CFP — 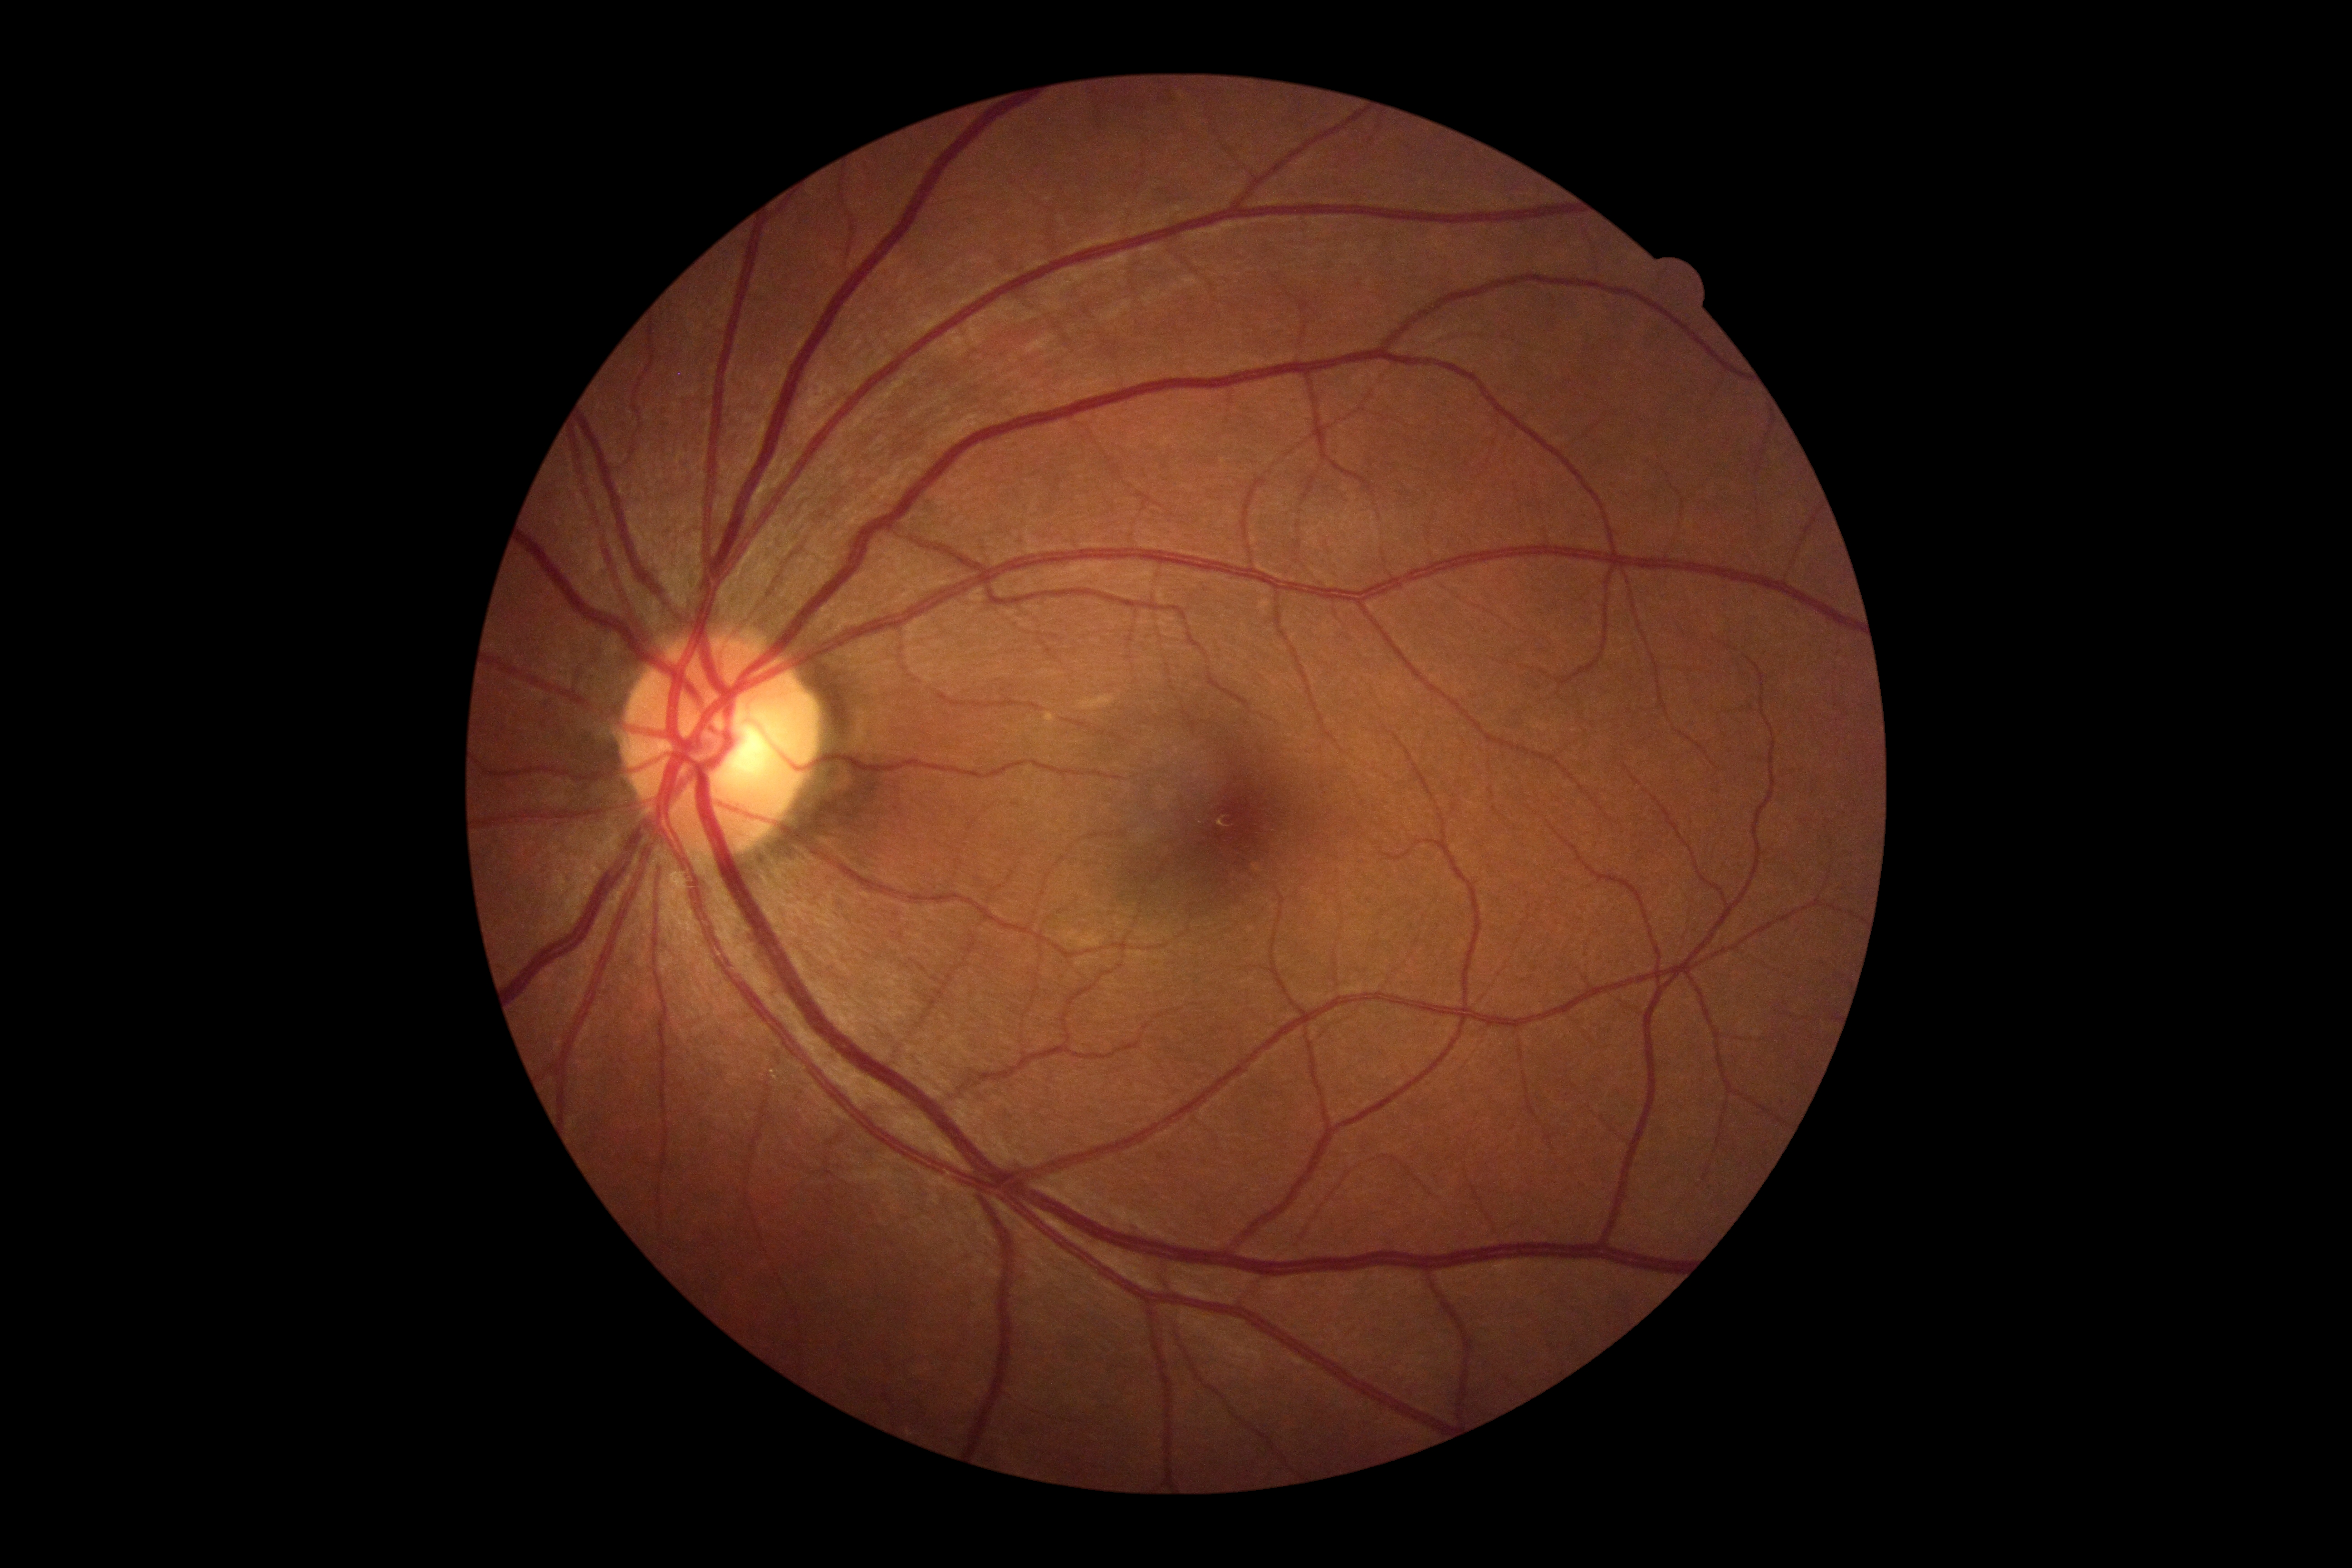

Diabetic retinopathy (DR) is grade 0.